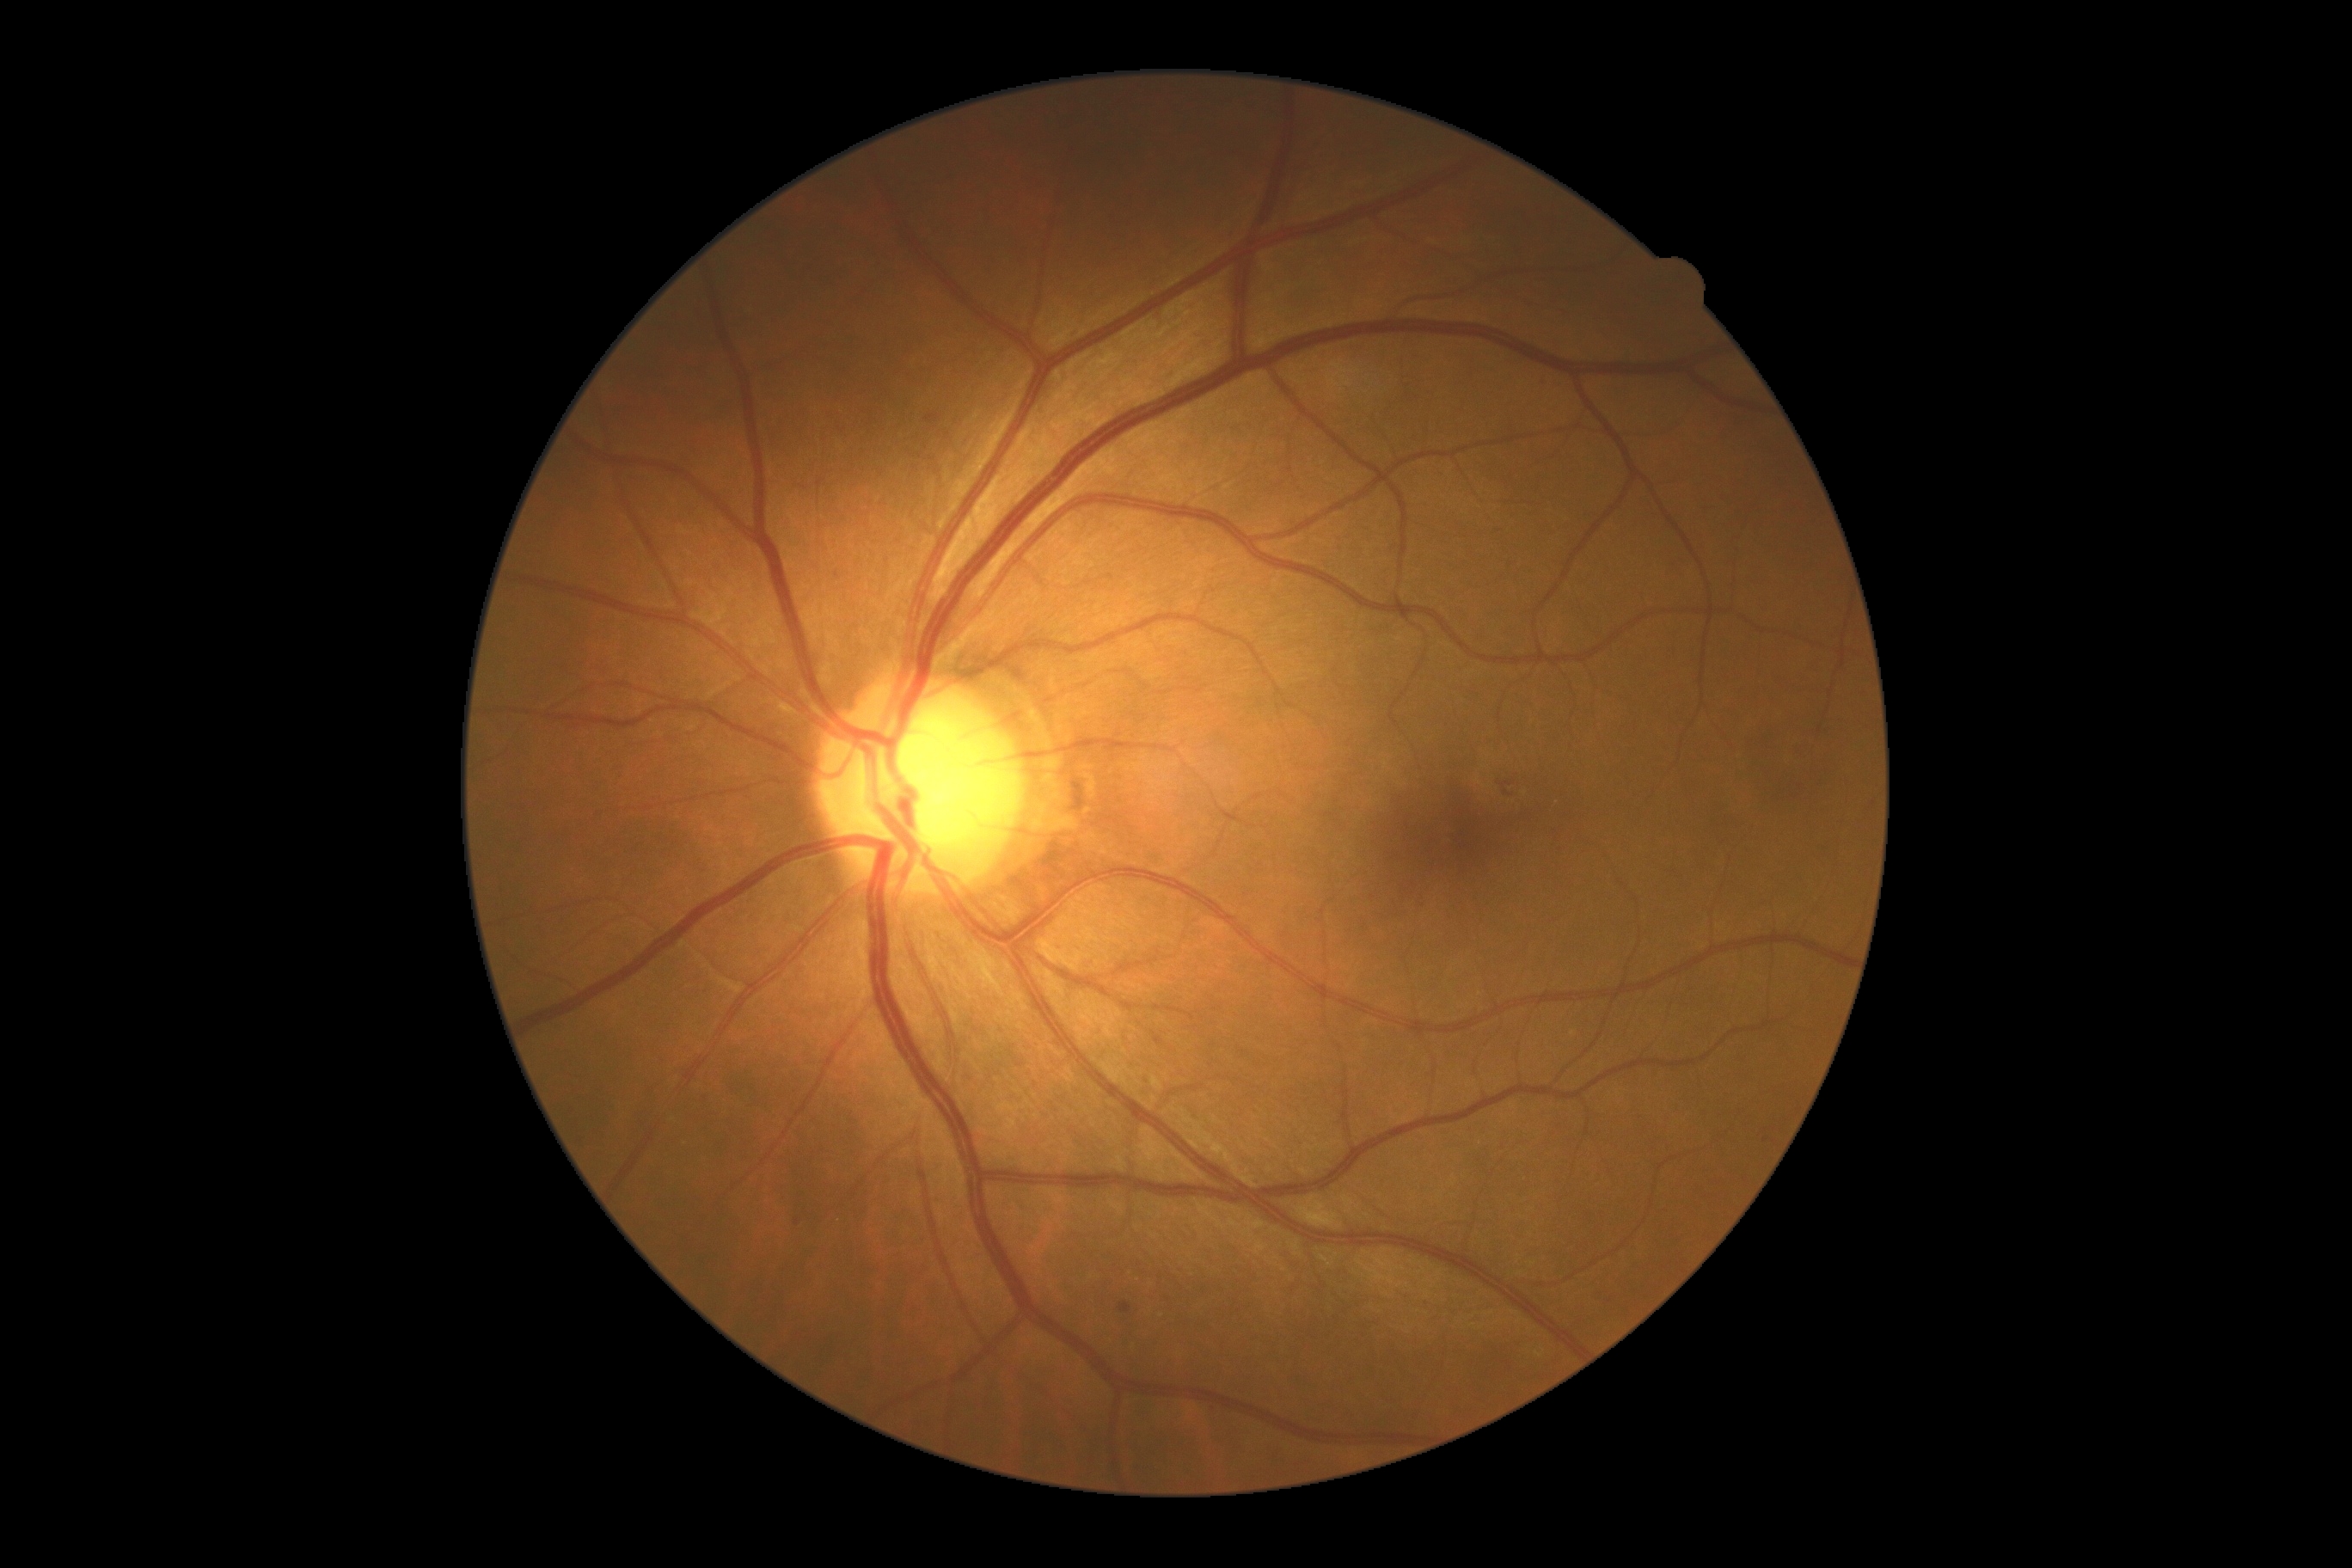

DR severity=grade 2.